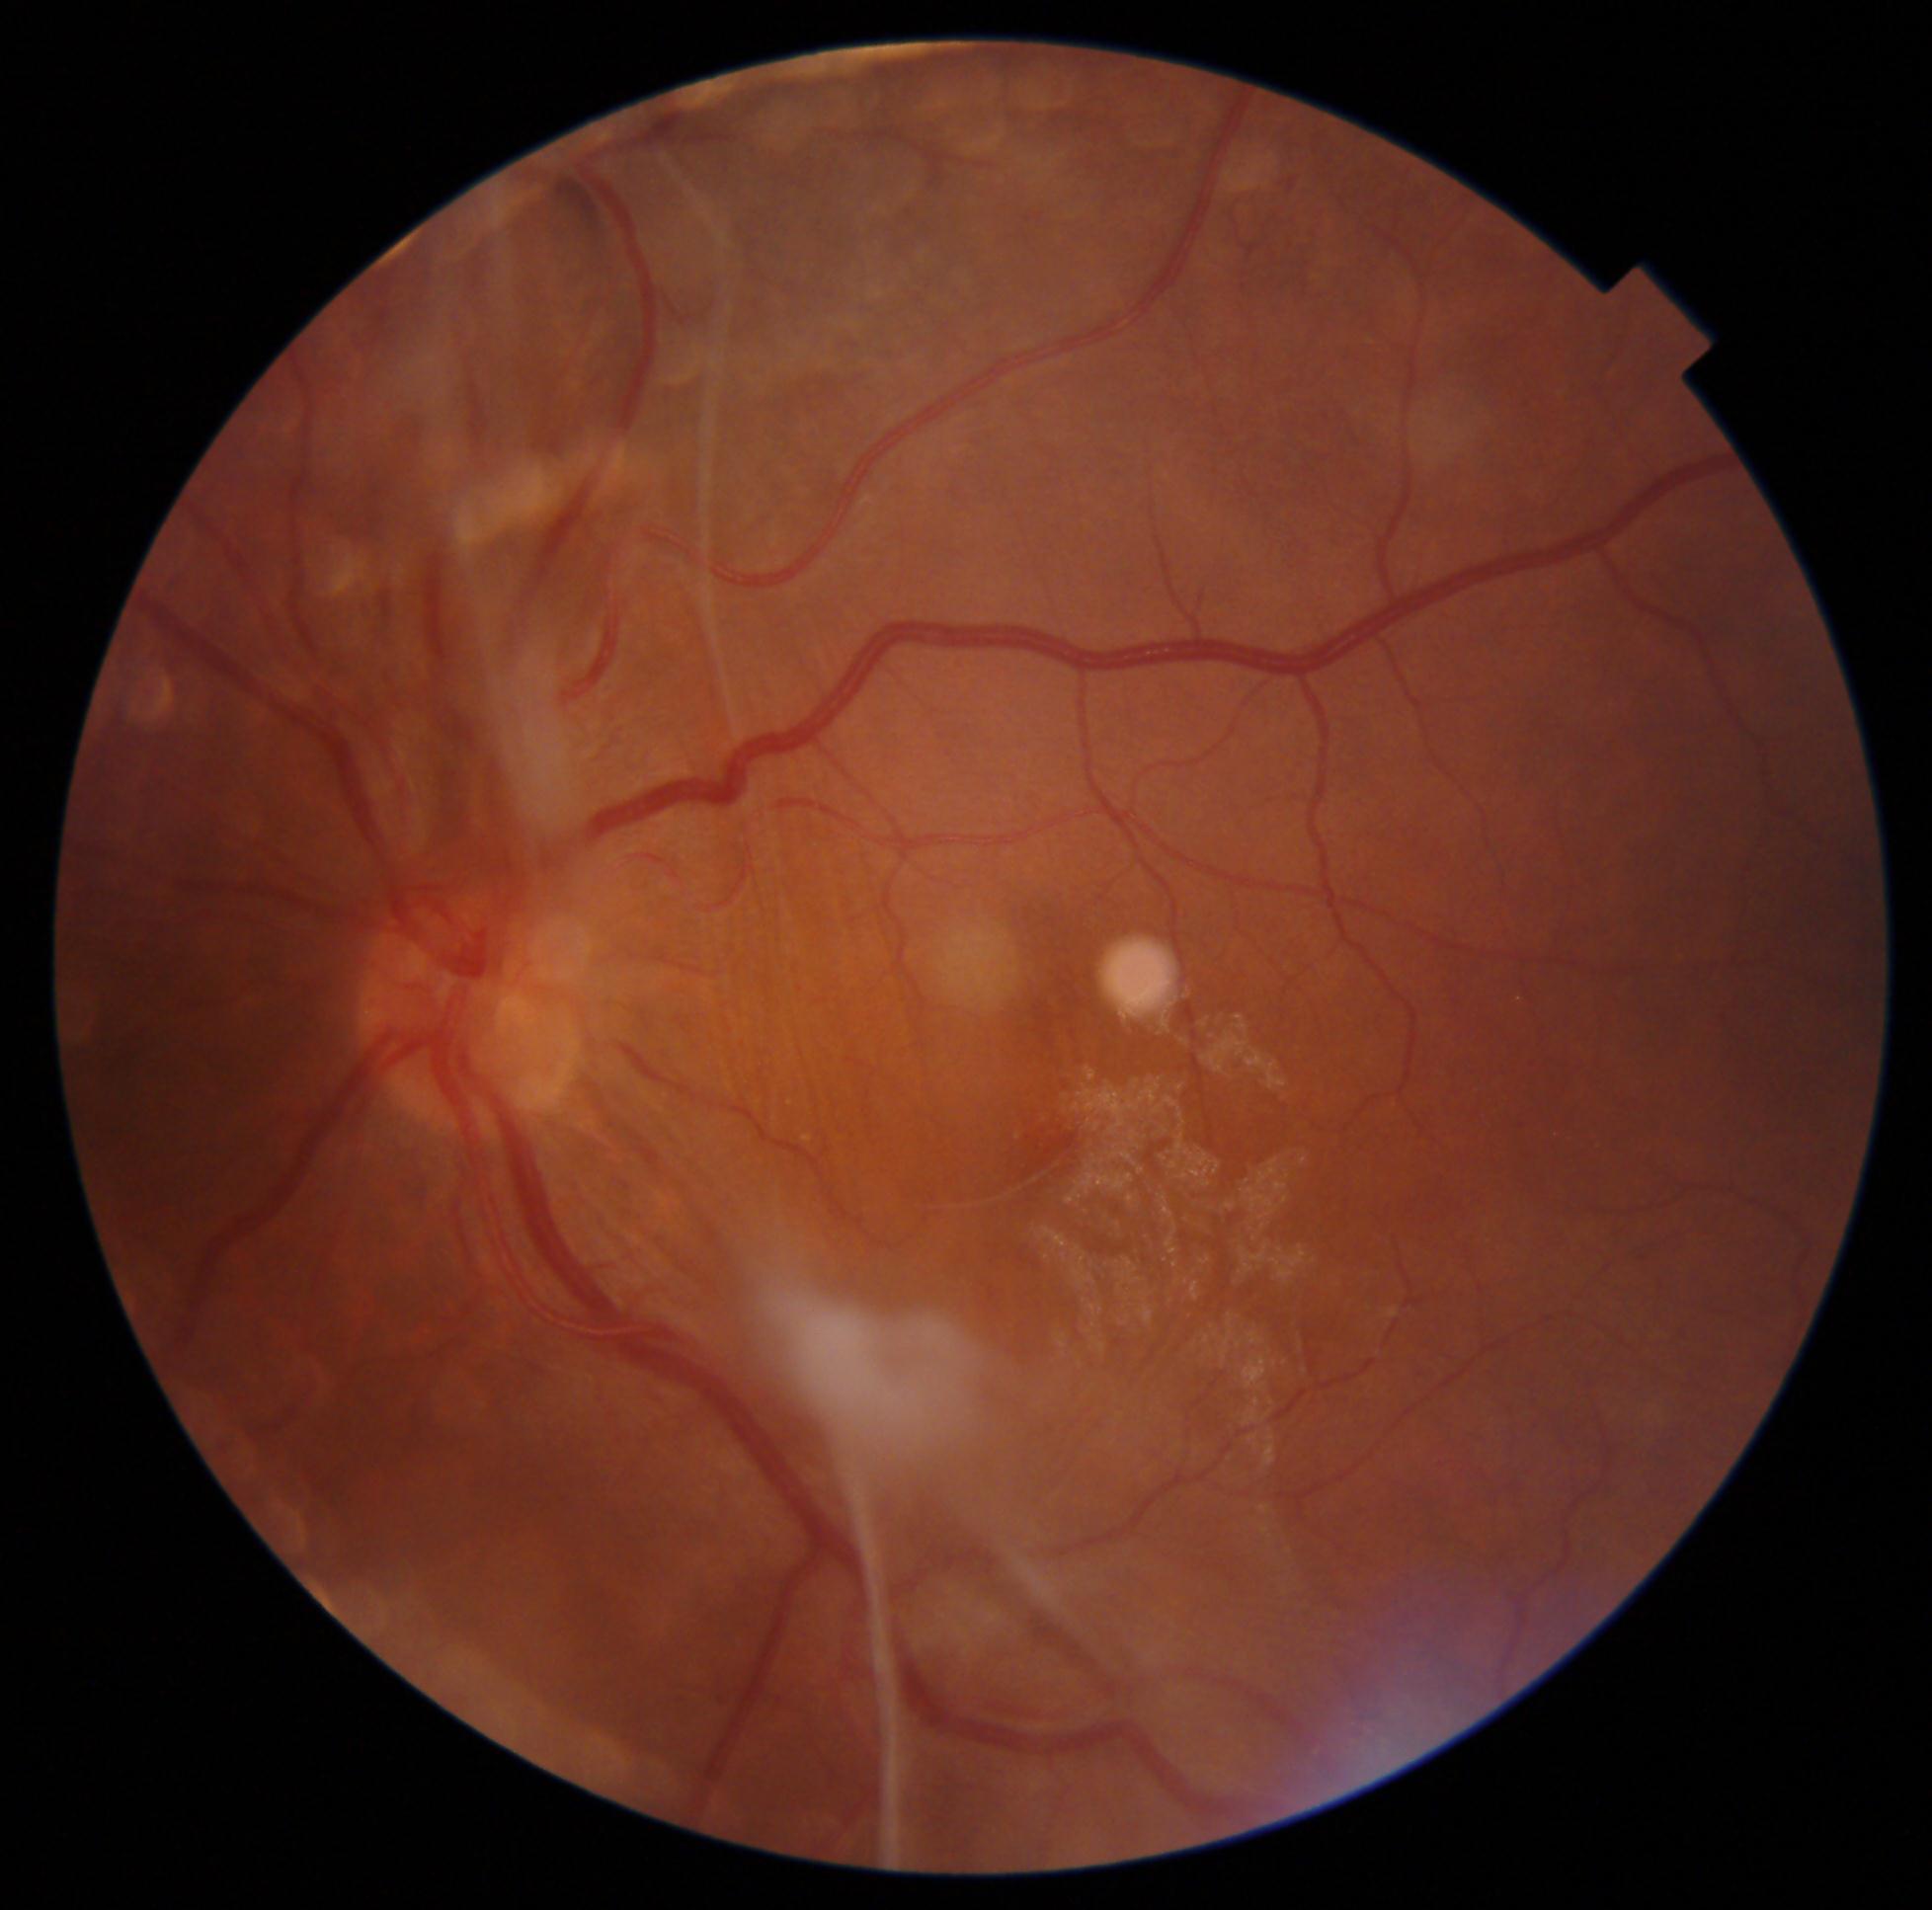

DR class: proliferative diabetic retinopathy. Diabetic retinopathy (DR) is grade 4.